Graded on the modified Davis scale
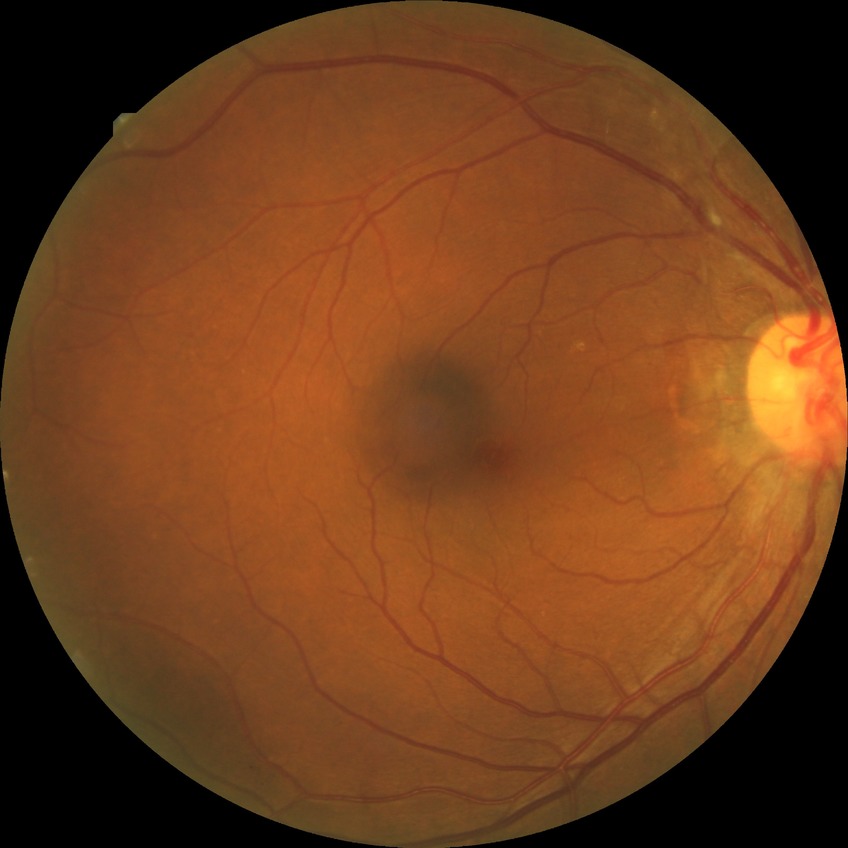
Davis grading: no diabetic retinopathy.